Davis DR grading. CFP — 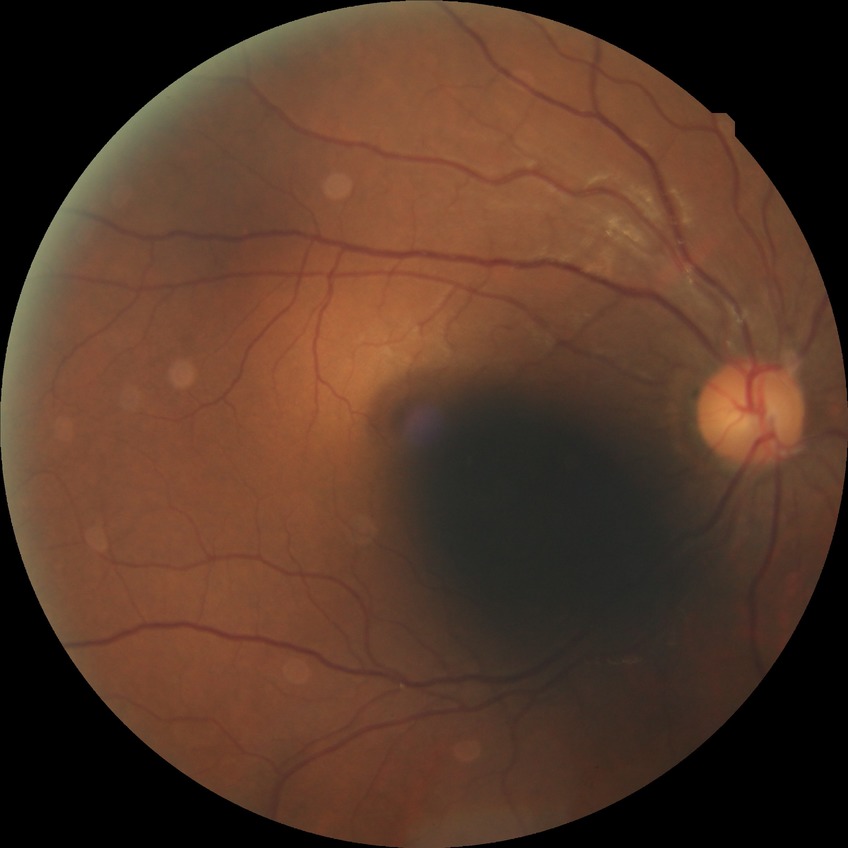

Diabetic retinopathy (DR) is no diabetic retinopathy (NDR).